CFP.
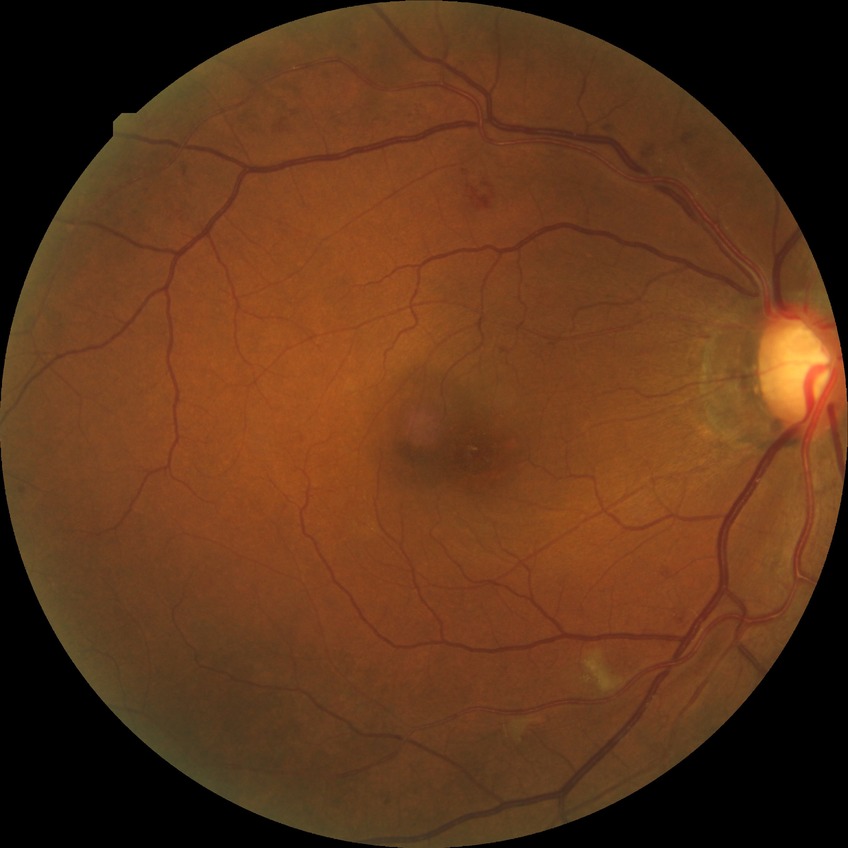

Annotations:
• DR grade — PPDR
• DR class — non-proliferative diabetic retinopathy